2352x1568px · 45° FOV · color fundus photograph: 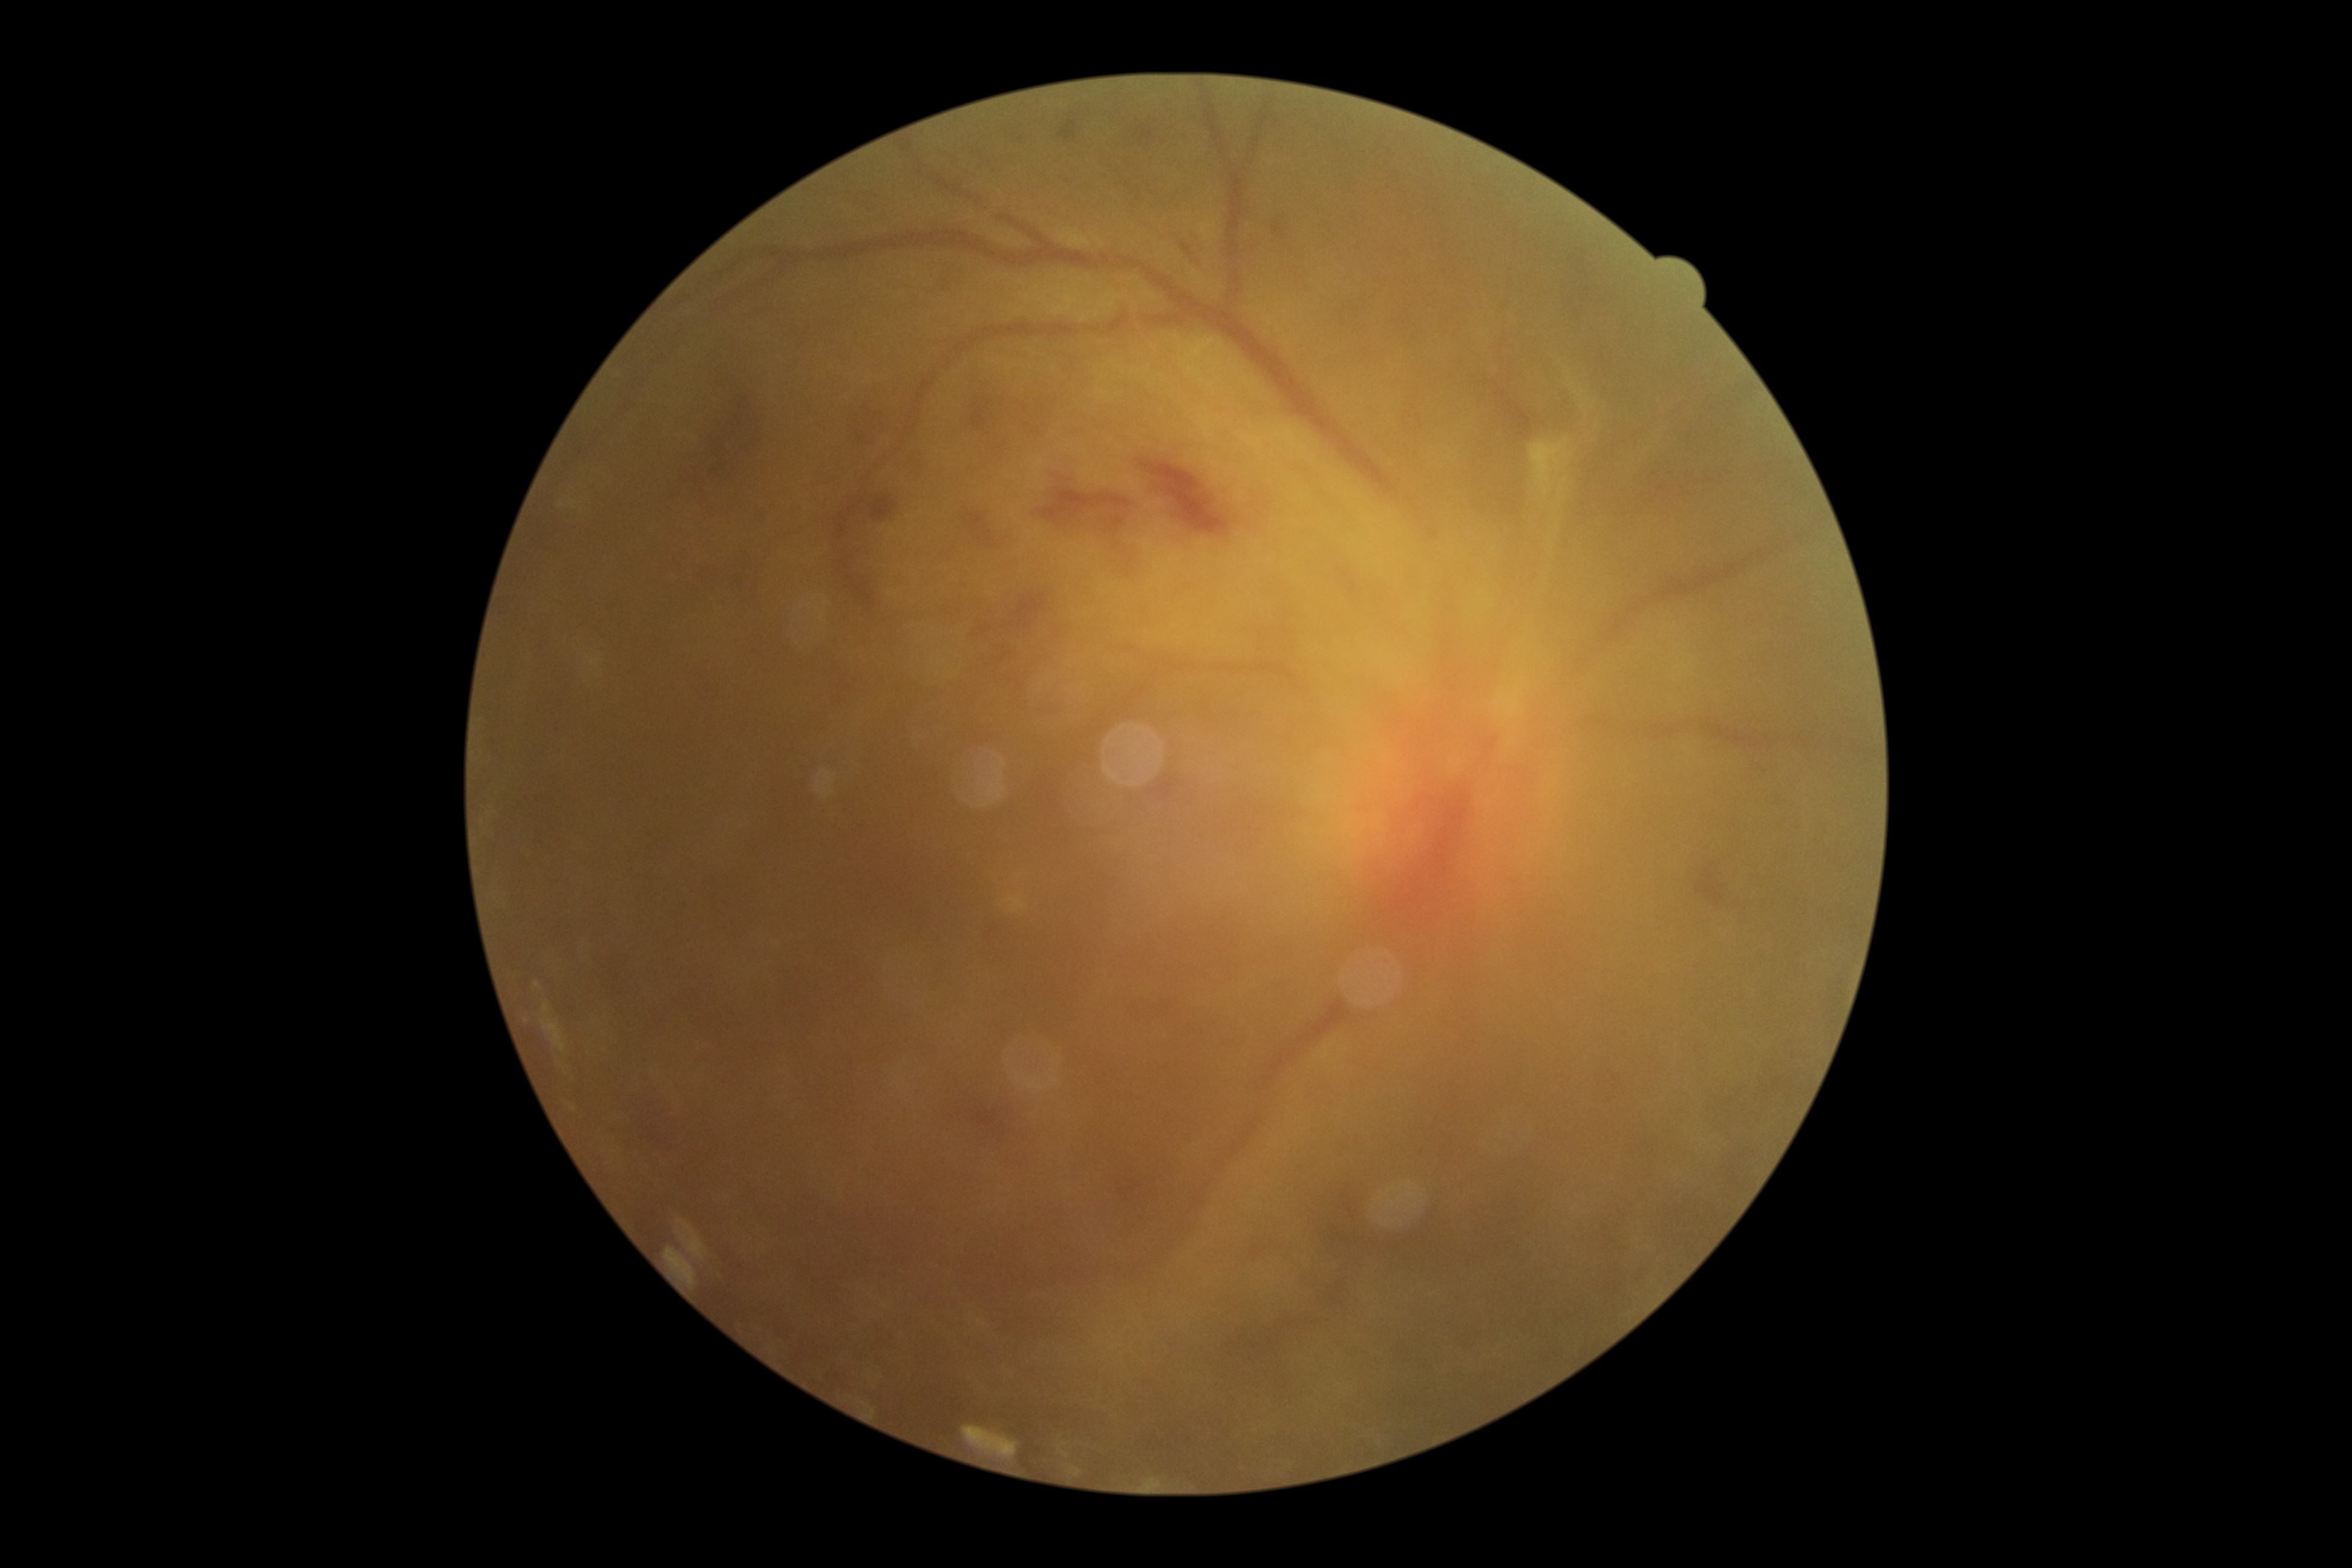

Retinopathy: 4/4 — neovascularization and/or vitreous/pre-retinal hemorrhage.